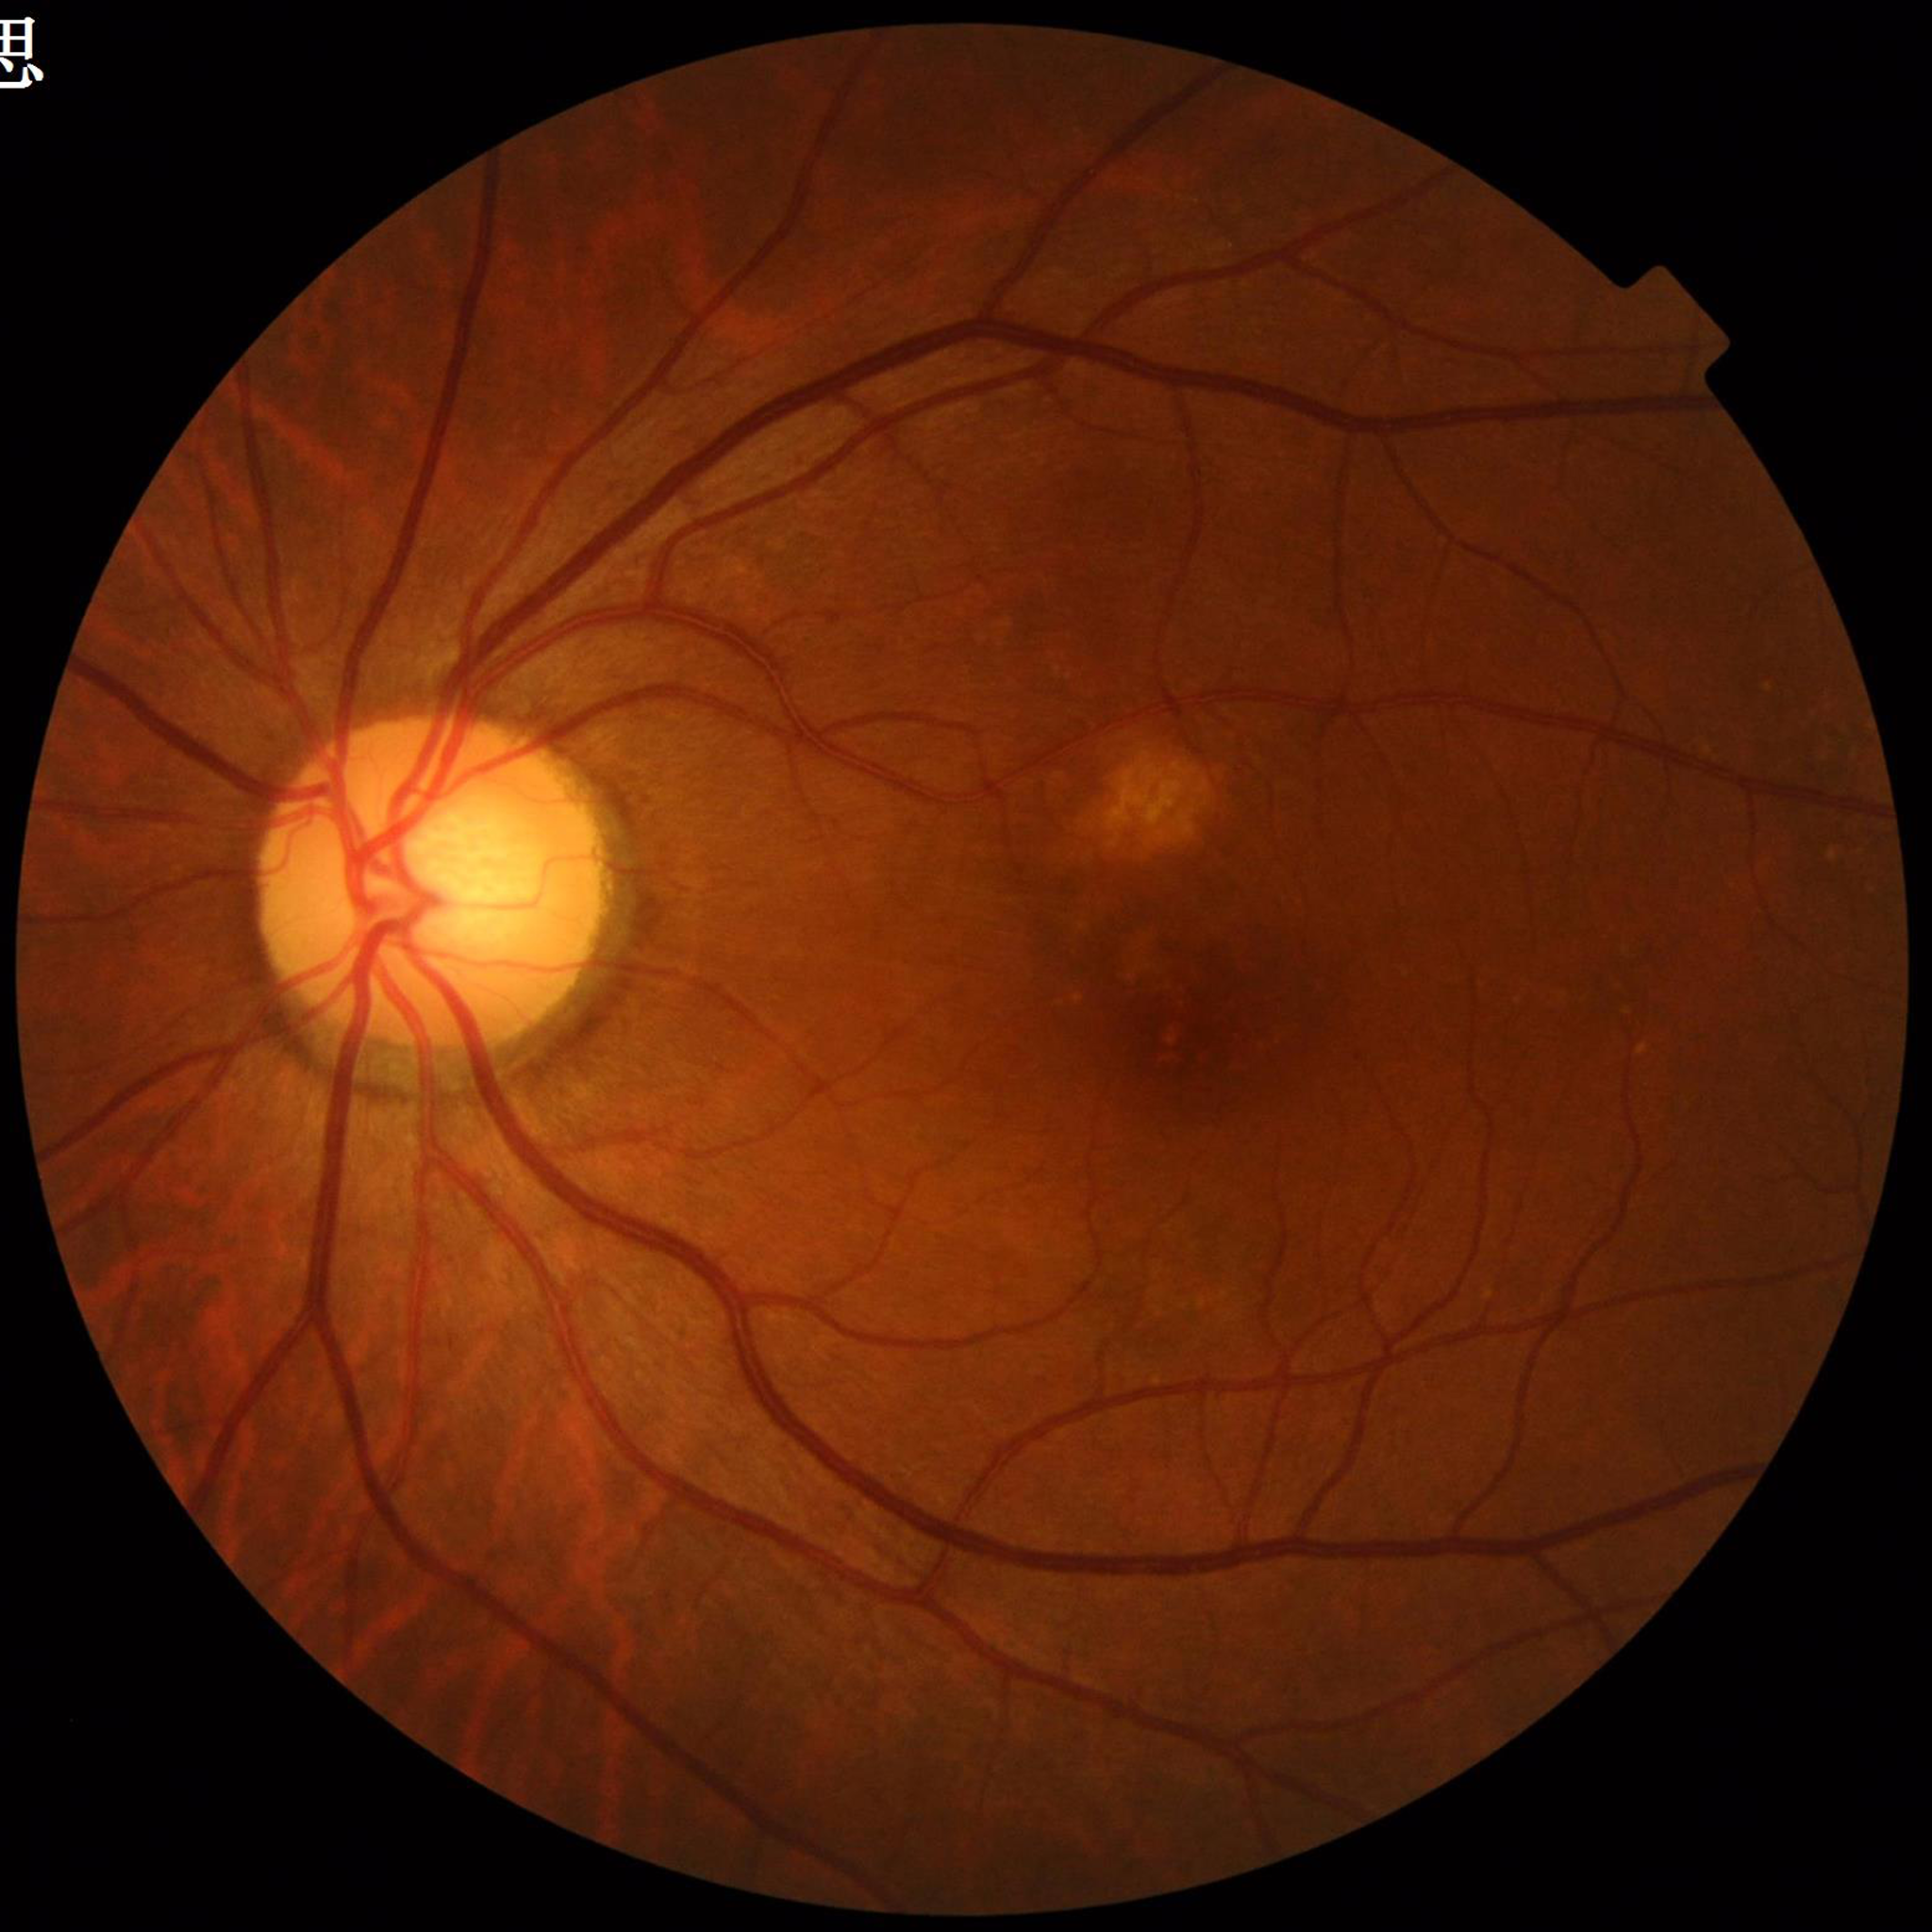
Disease class: AMD